Modified Davis classification:
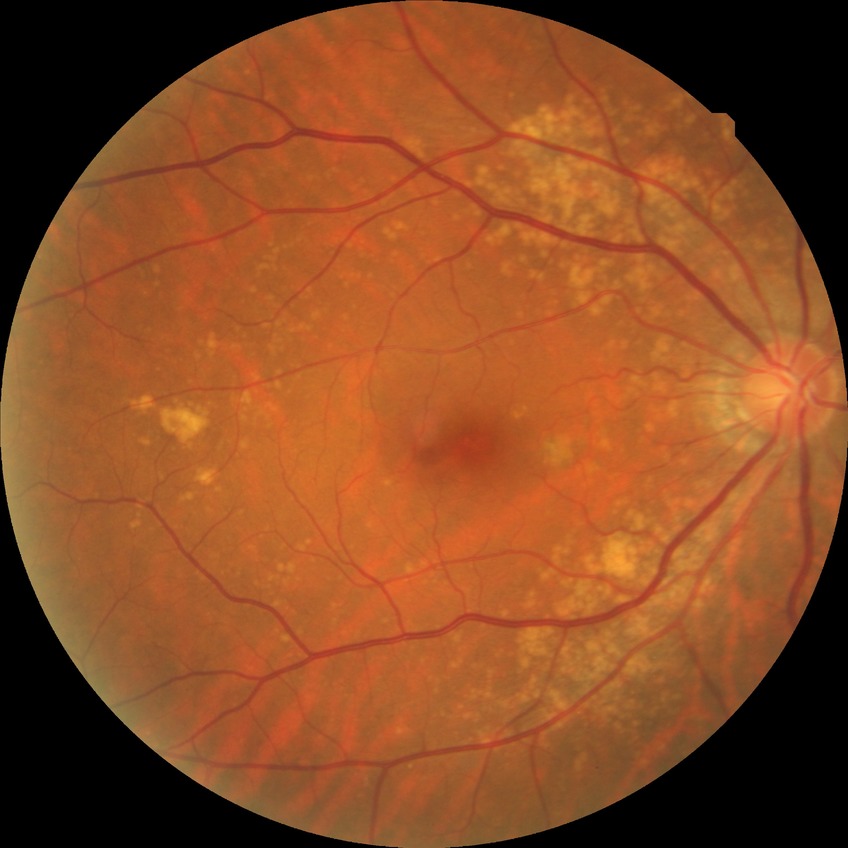 diabetic retinopathy severity = no diabetic retinopathy